Field includes the optic disc and macula, dilated-pupil acquisition, acquired with a Topcon TRC-50DX, 50° FOV, color fundus photograph — 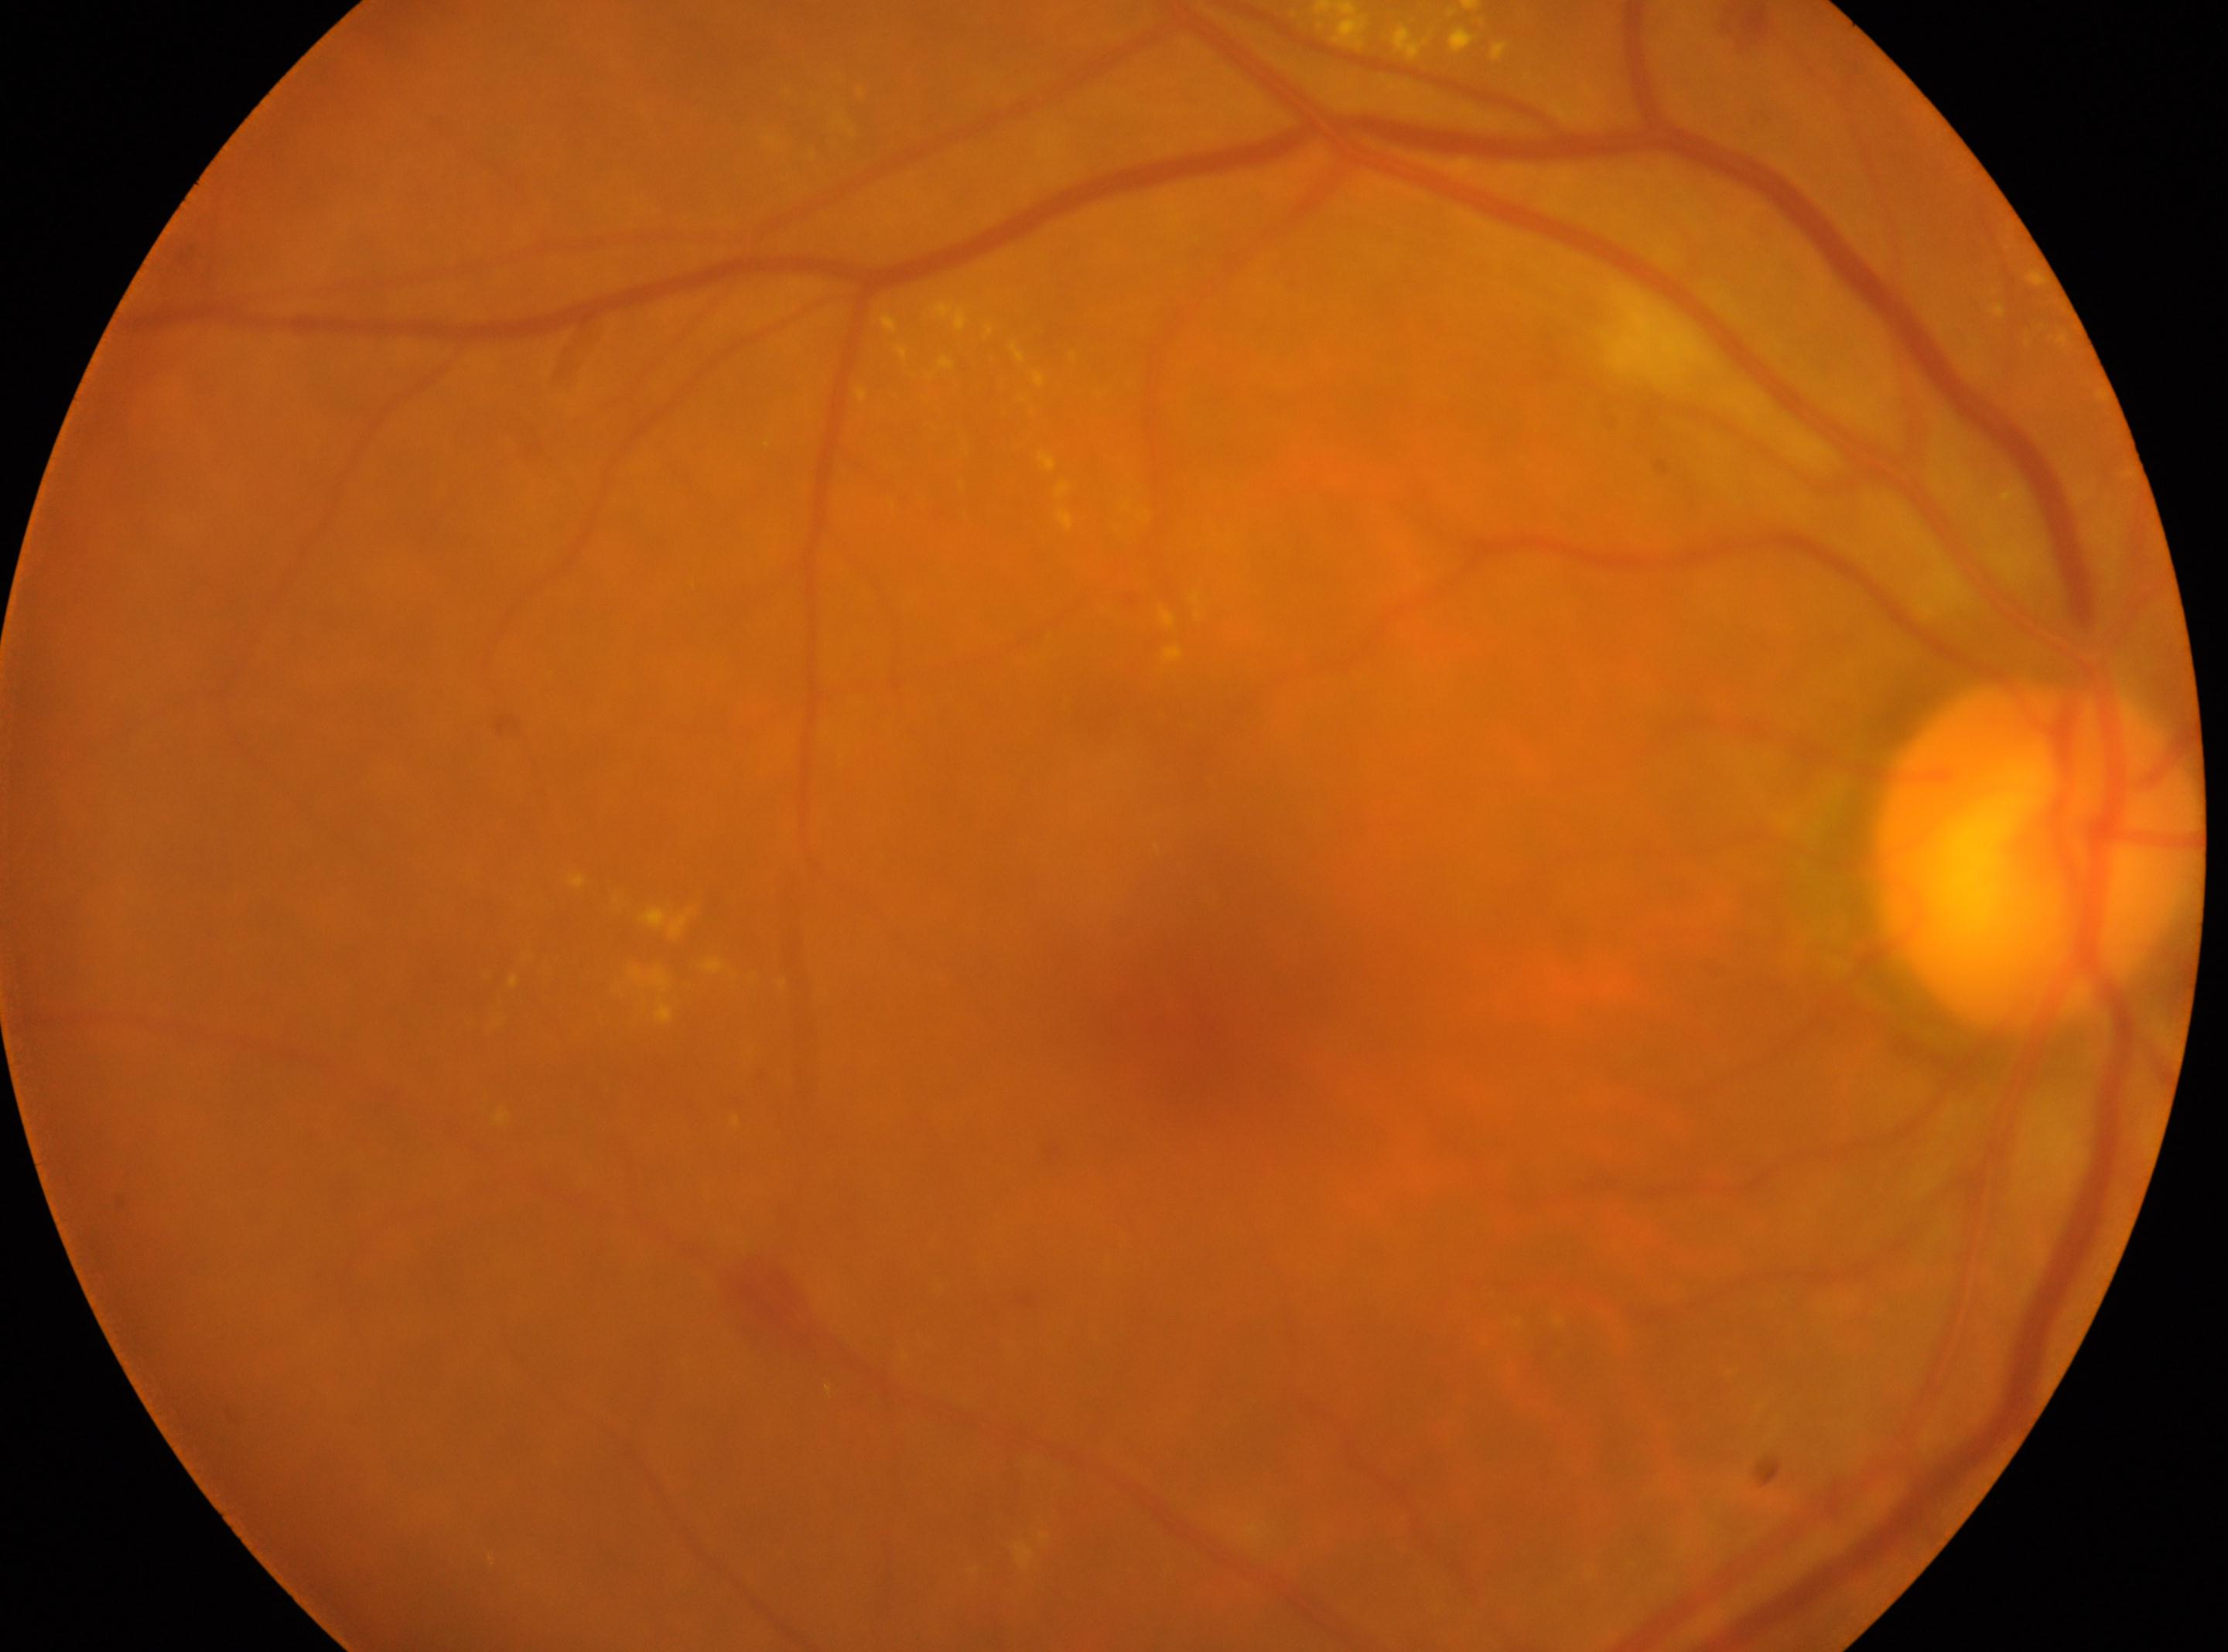

Optic disc: (2036, 855).
Imaged eye: right eye.
DR class: non-proliferative diabetic retinopathy.
DR is 2.
Macular center located at (1202, 1029).